Fundus photo; 45-degree field of view; DR severity per modified Davis staging
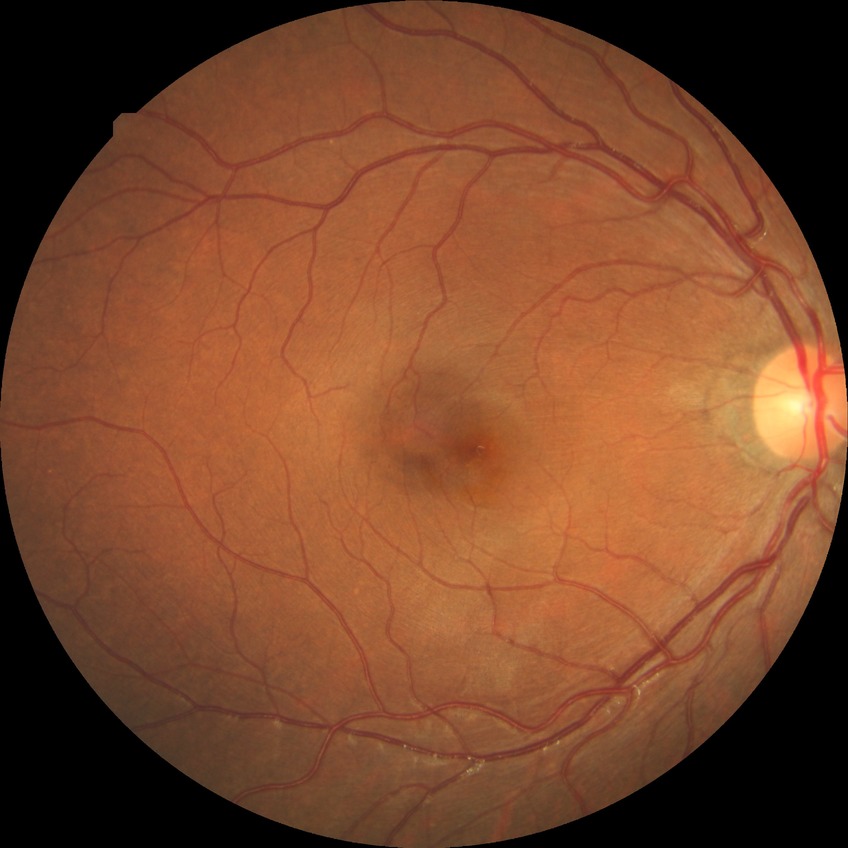 DR severity is NDR.